Non-mydriatic acquisition: 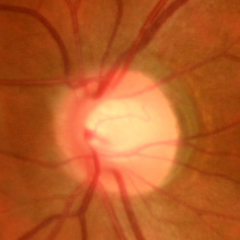
Demonstrates no glaucomatous changes.